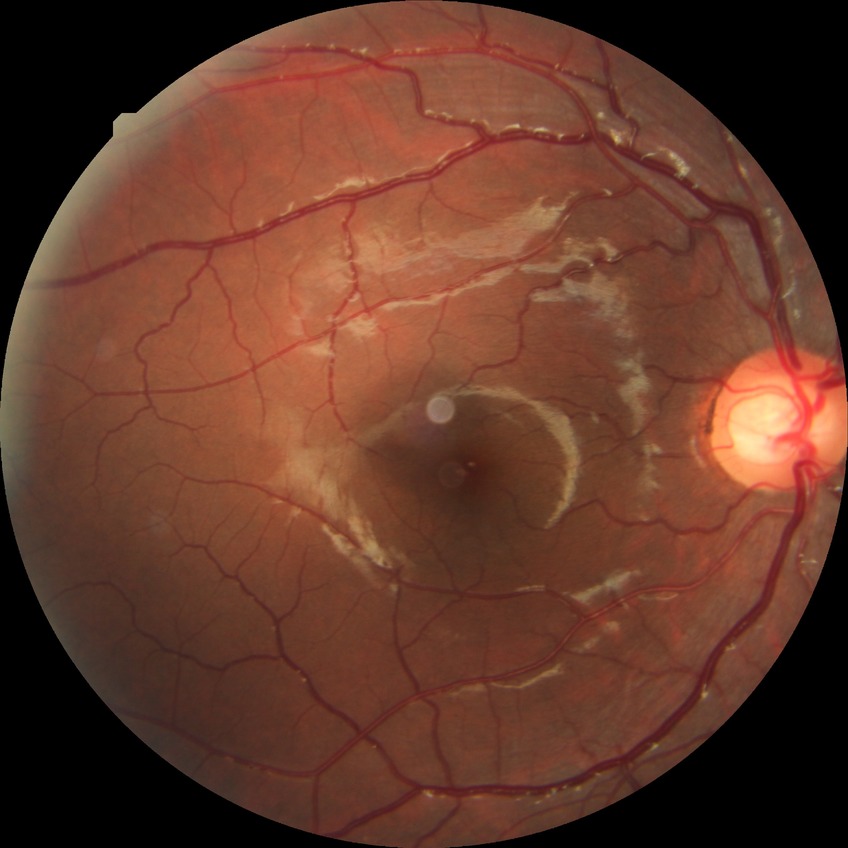 Diabetic retinopathy (DR) is no diabetic retinopathy (NDR).